NIDEK AFC-230 — 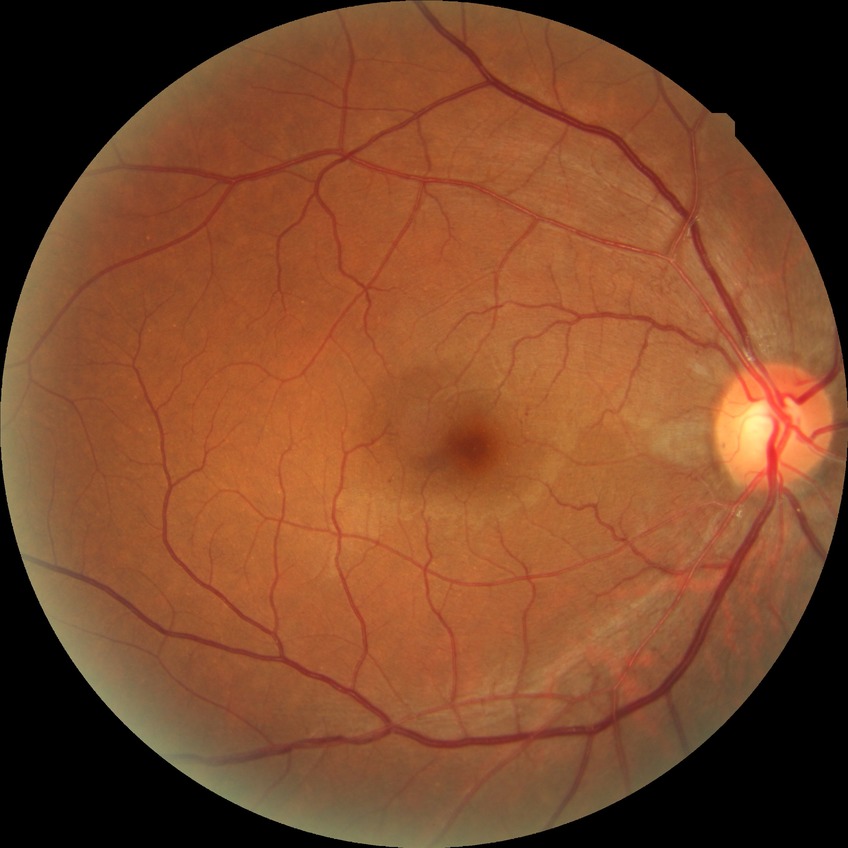
DR class: non-proliferative diabetic retinopathy.
Retinopathy grade is simple diabetic retinopathy.